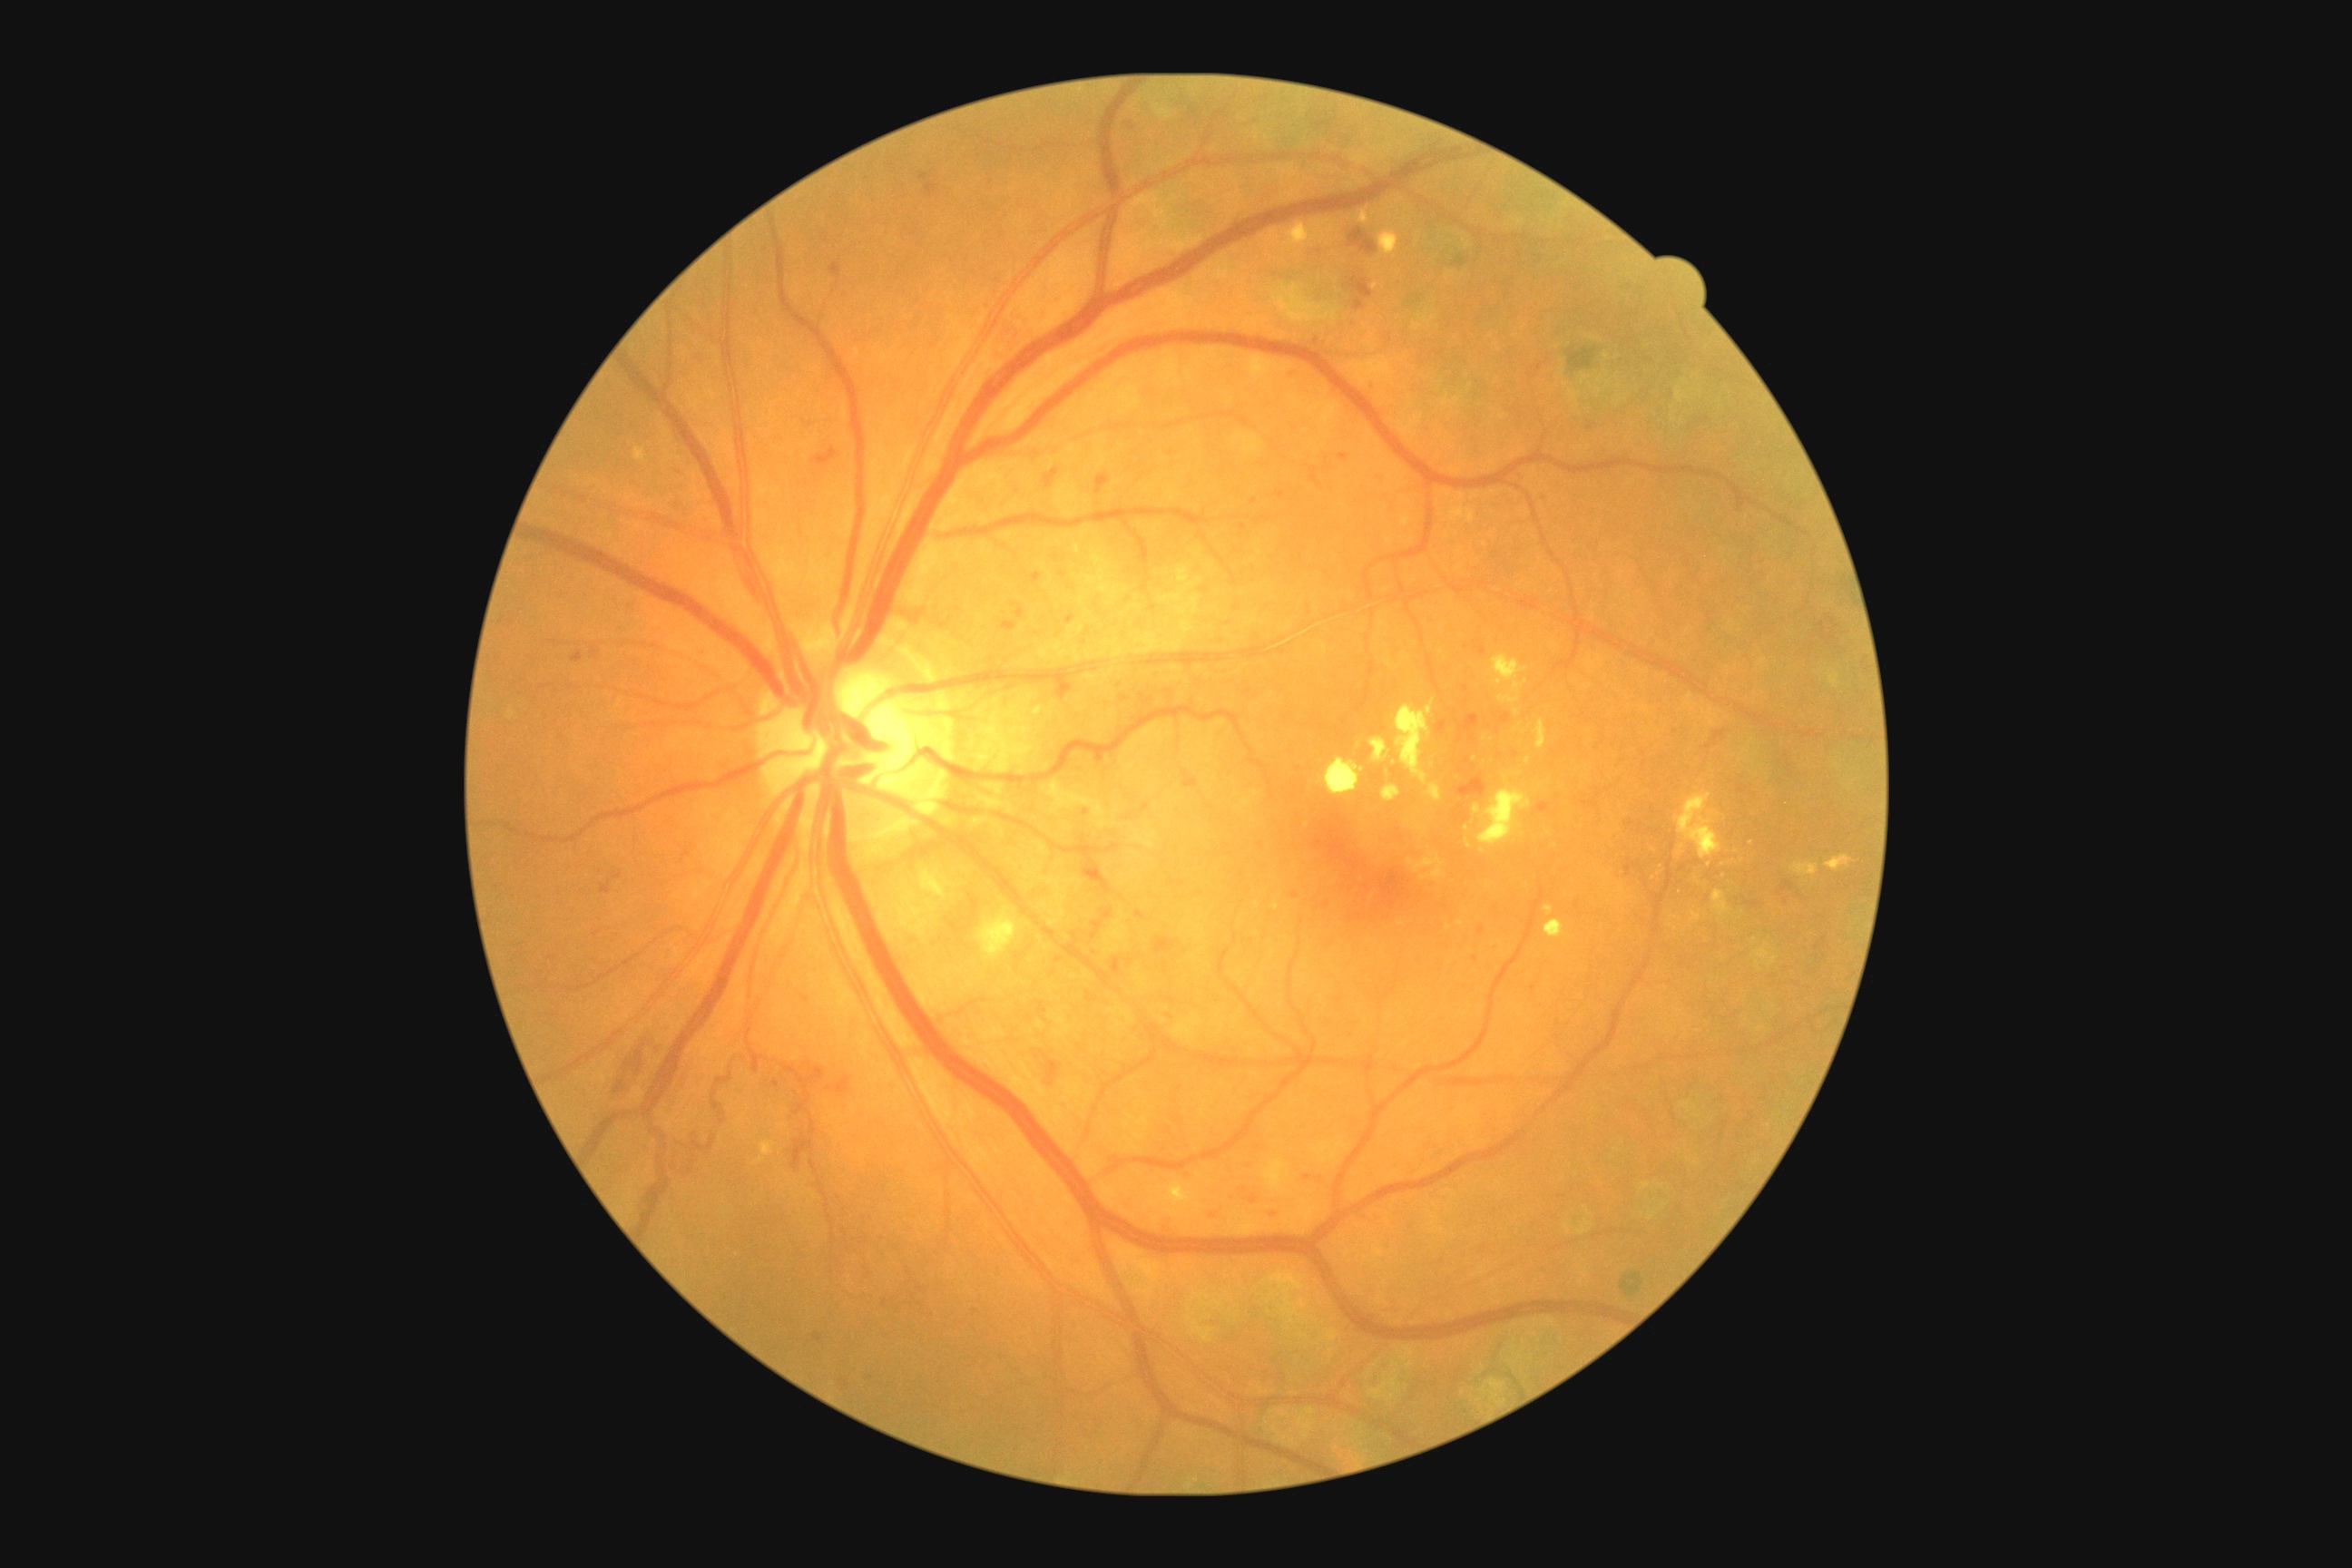 Diabetic retinopathy (DR): 3/4
Lesions identified (partial list):
hemorrhages (HEs) (partial) = box(612, 872, 623, 879), box(1475, 647, 1487, 656), box(1224, 1193, 1237, 1206), box(1102, 908, 1113, 921), box(999, 622, 1017, 632), box(814, 1333, 821, 1342), box(1097, 475, 1110, 495), box(1455, 814, 1458, 823), box(1536, 803, 1551, 814), box(665, 1141, 701, 1177), box(1092, 923, 1102, 939), box(1155, 939, 1177, 954), box(1458, 778, 1487, 798), box(1818, 622, 1836, 645)
Smaller HEs around [1466, 689], [1476, 960], [1281, 494]
hard exudates (EXs) (partial) = box(1534, 720, 1547, 750), box(1032, 701, 1044, 718), box(1357, 210, 1369, 224), box(1382, 785, 1402, 801), box(1465, 839, 1471, 848), box(1482, 734, 1493, 741), box(1326, 760, 1366, 796), box(1674, 794, 1721, 859), box(1825, 856, 1854, 872)
Smaller EXs around [1531, 727], [1525, 733], [1528, 761], [1467, 828], [1307, 825]